1440x1080px · infant wide-field fundus photograph · captured with the Natus RetCam Envision (130° field of view) — 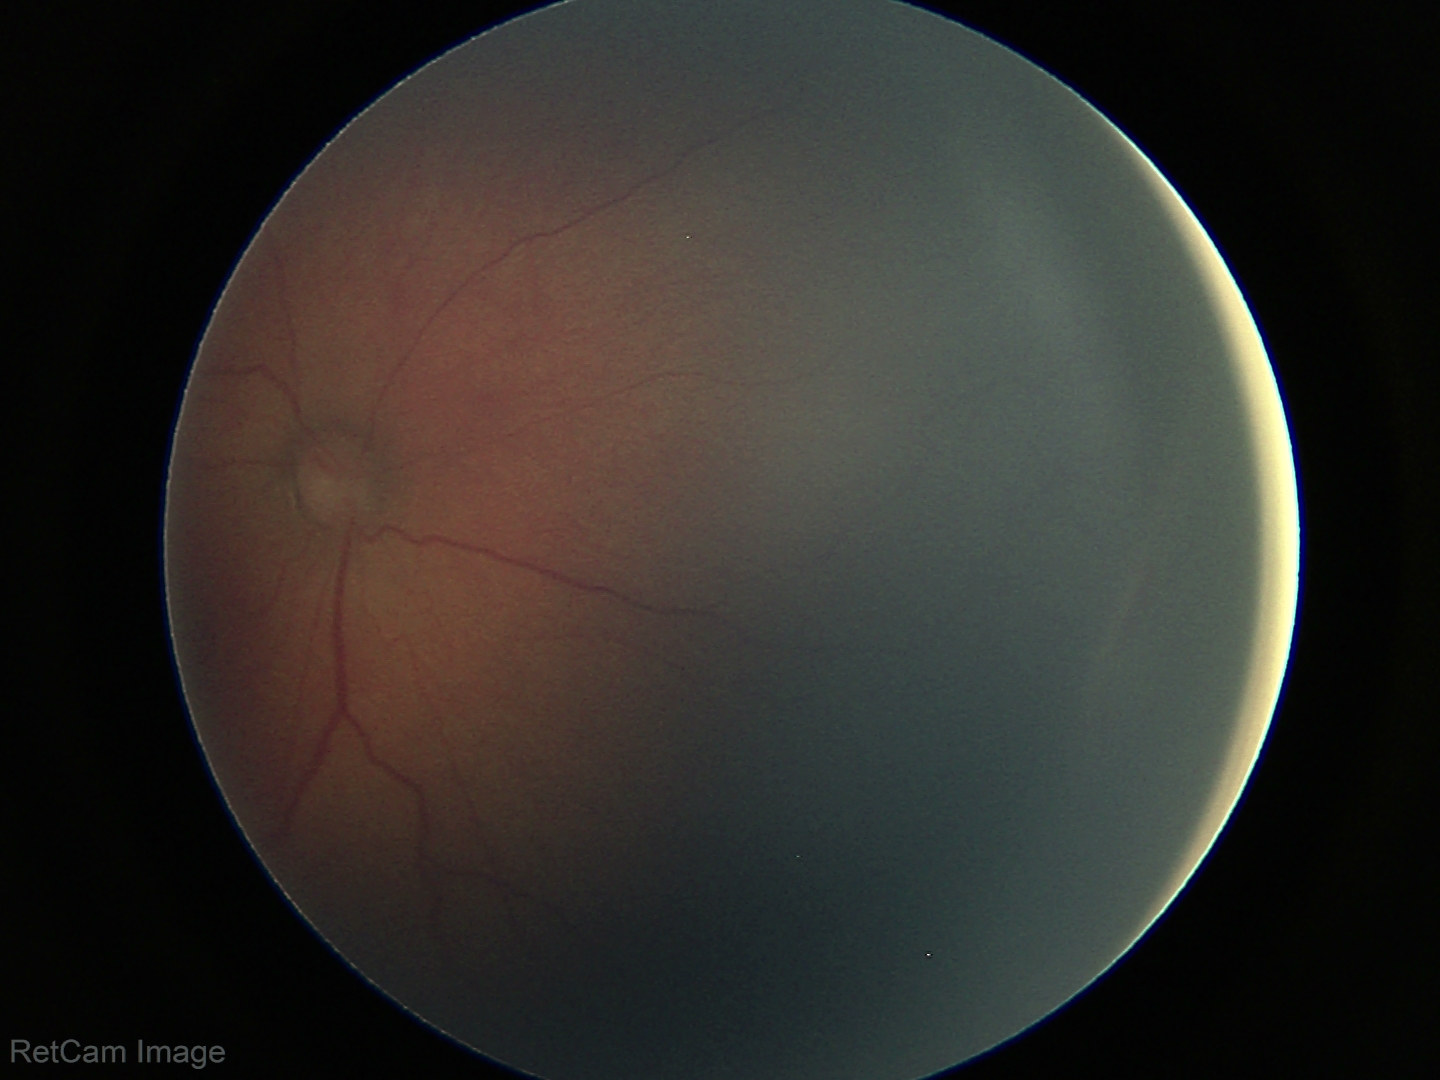

Series diagnosed as ROP stage 2.